Nonmydriatic fundus photograph.
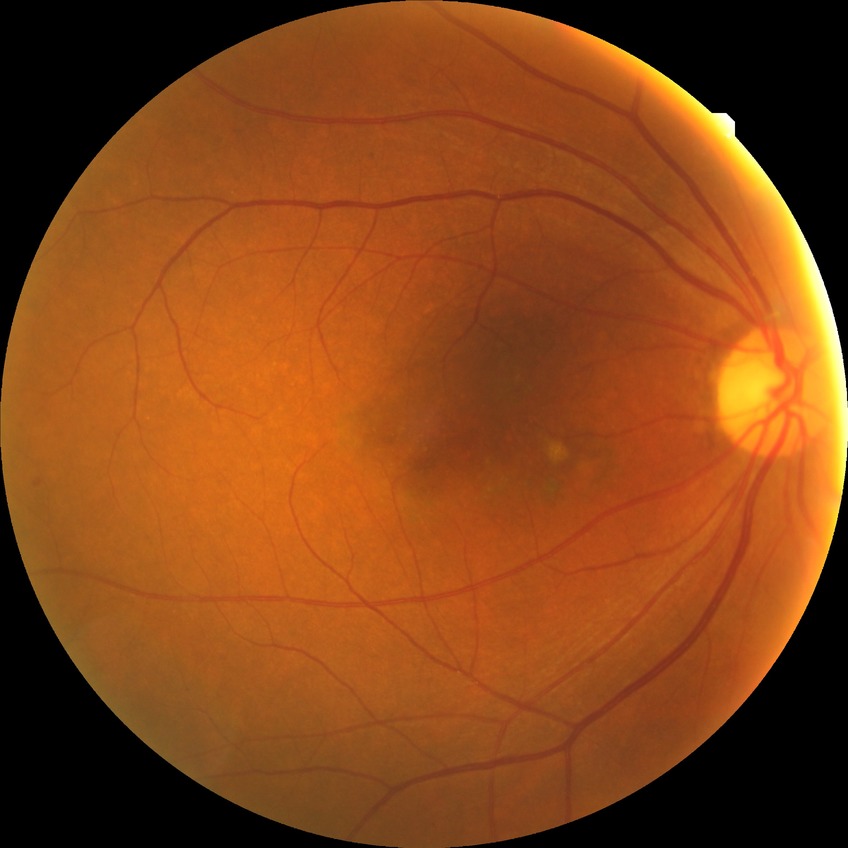

  davis_grade: no diabetic retinopathy